1240x1240. Pediatric wide-field fundus photograph. Phoenix ICON, 100° FOV — 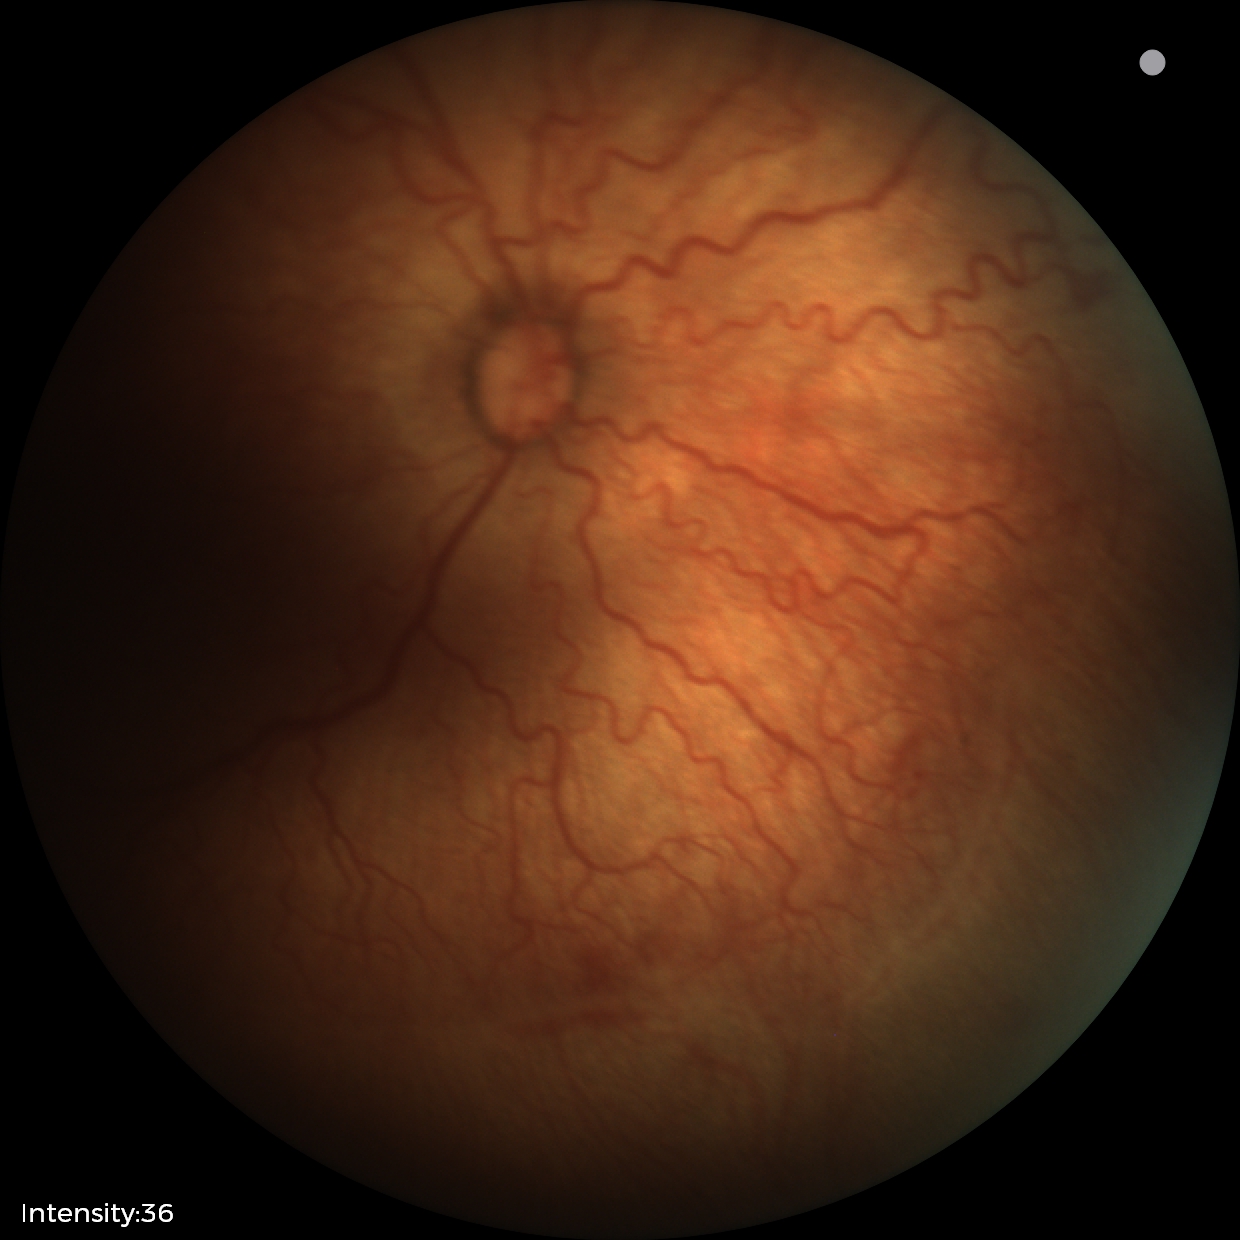

Retinopathy of prematurity = stage 2
plus form = present